45-degree field of view; CFP; image size 2212x1659.
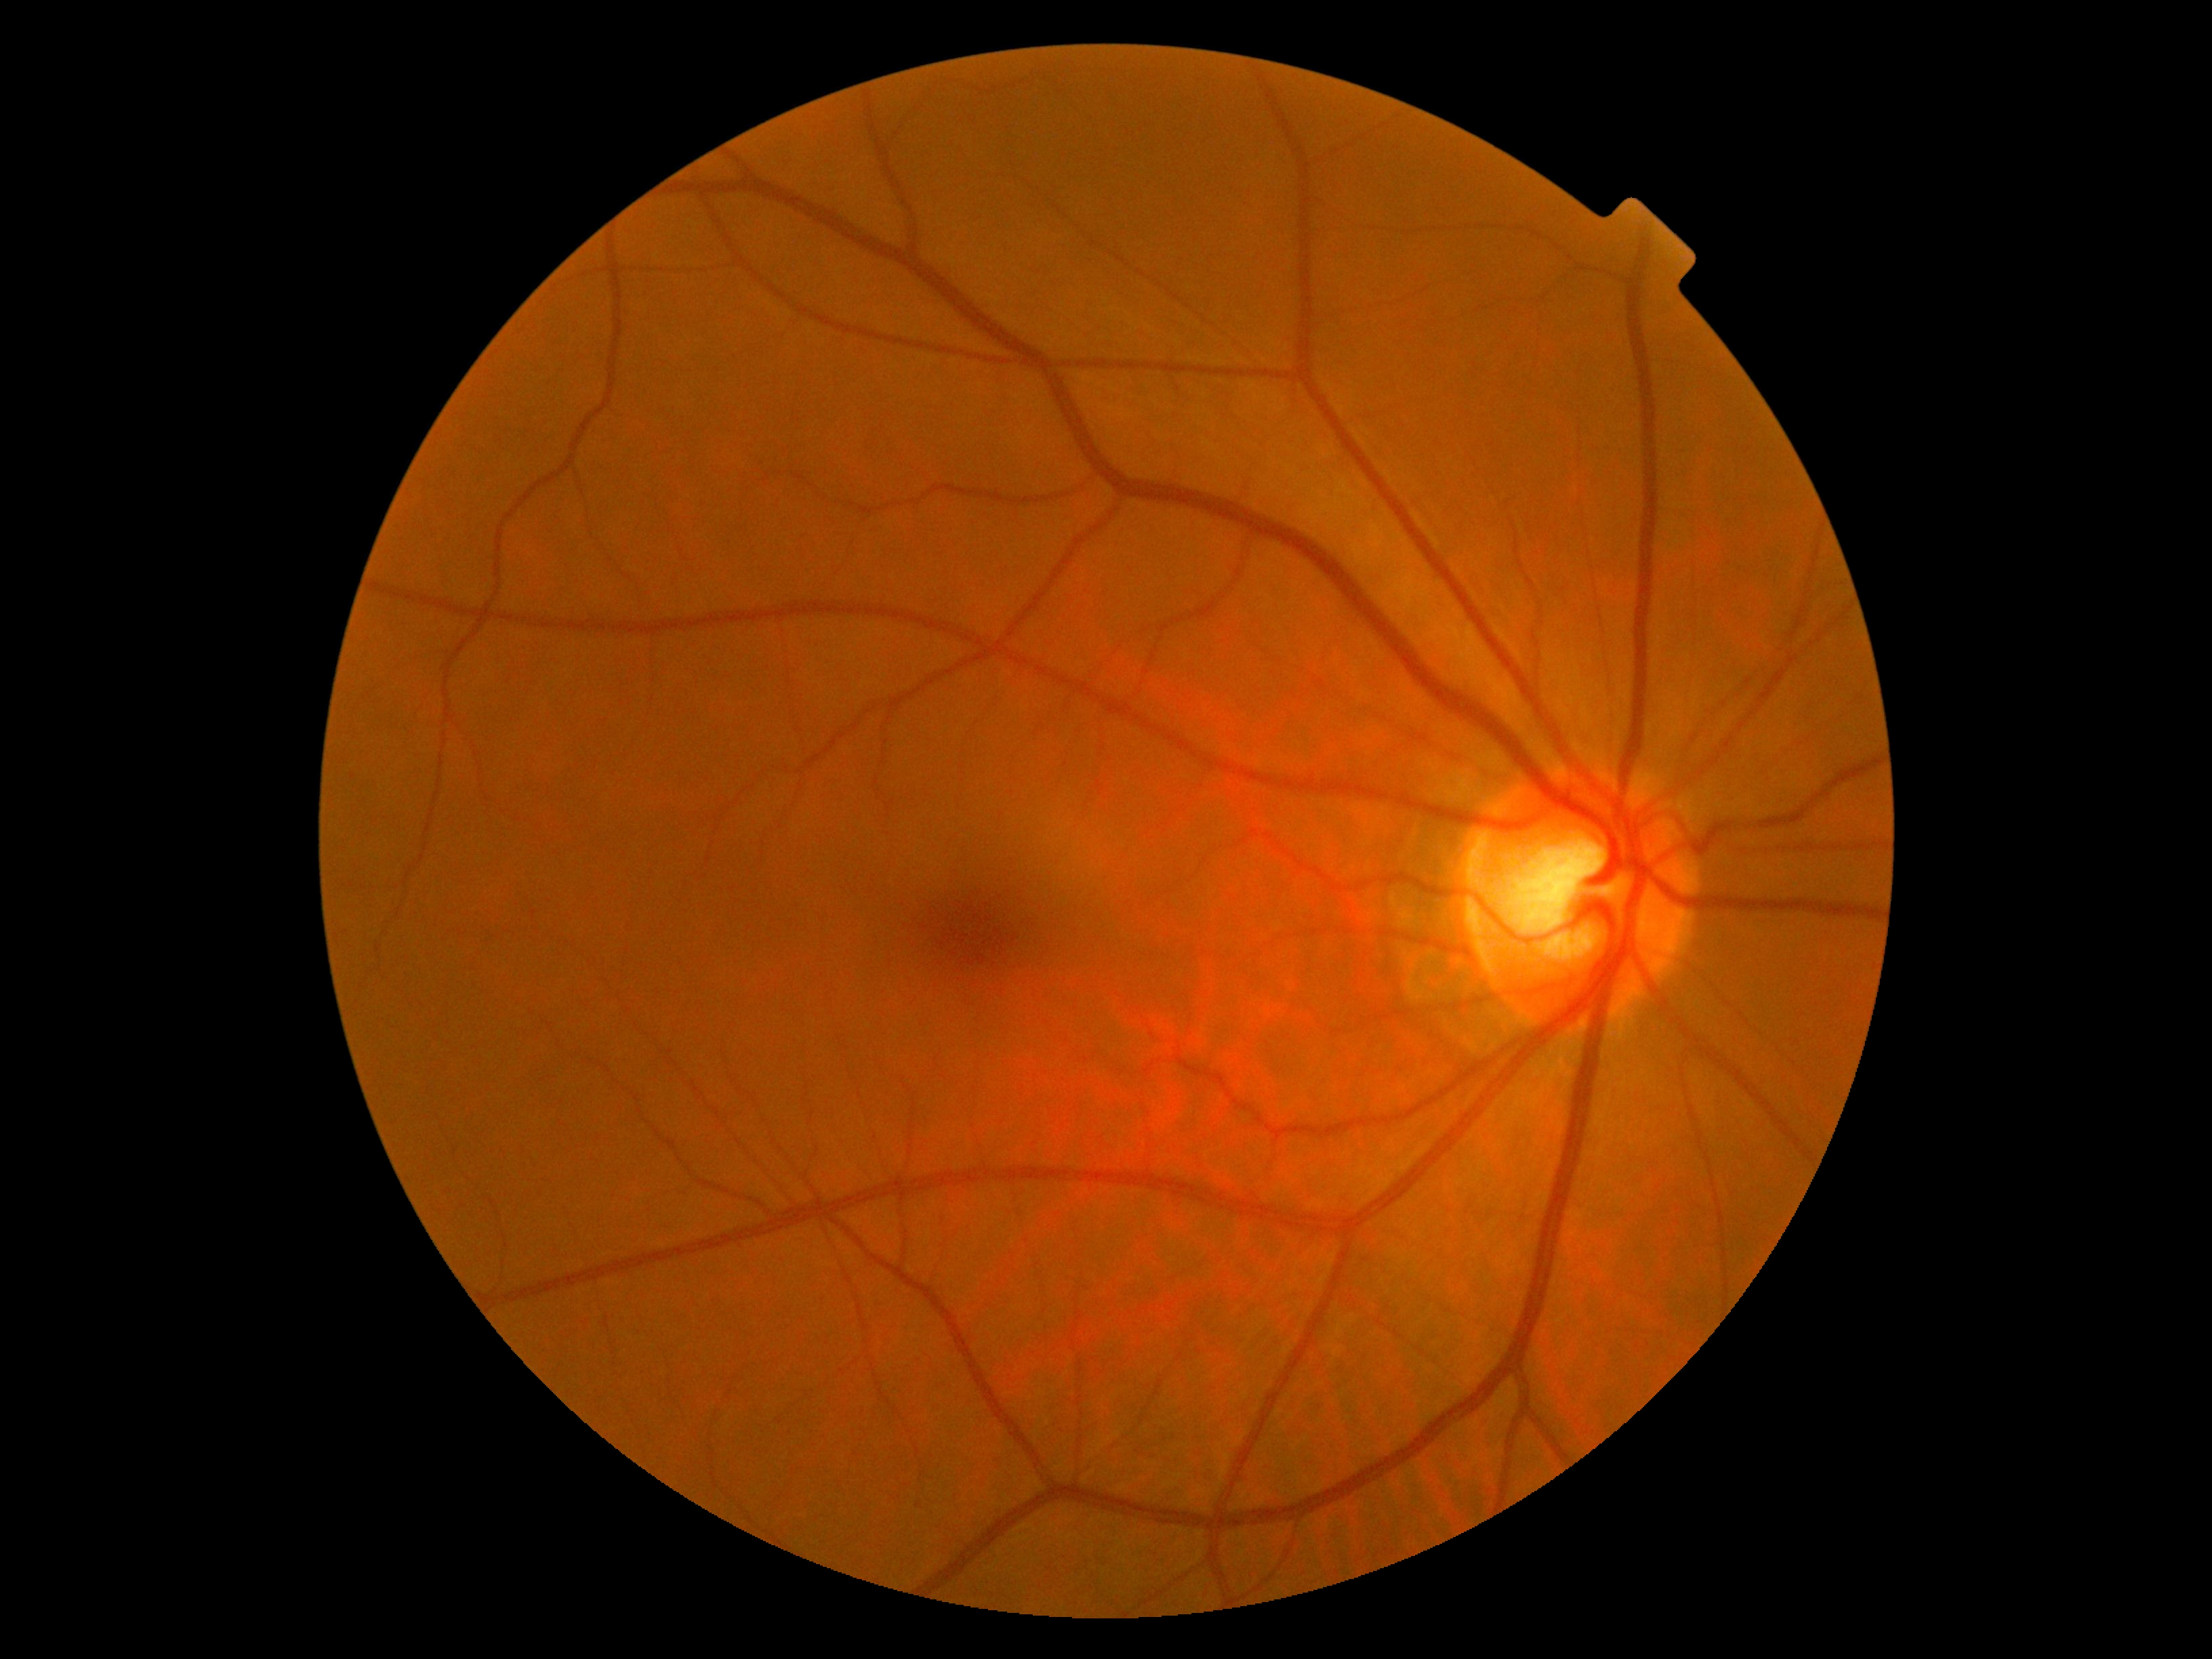 No apparent diabetic retinopathy.
DR stage is grade 0.